CFP: 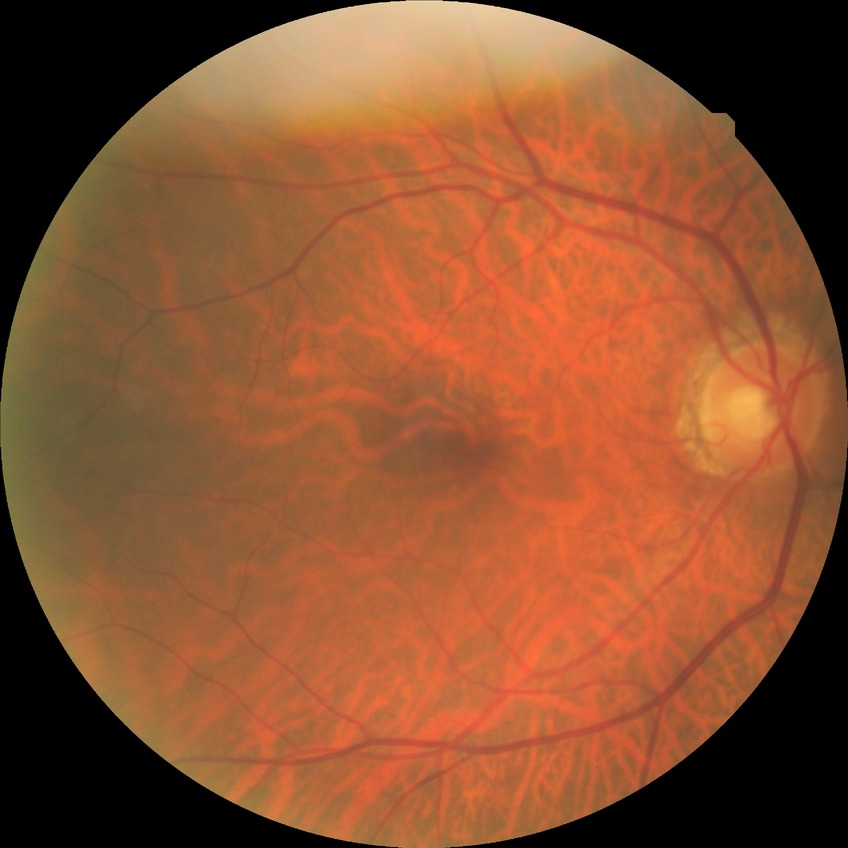 Diabetic retinopathy (DR) is no diabetic retinopathy (NDR).